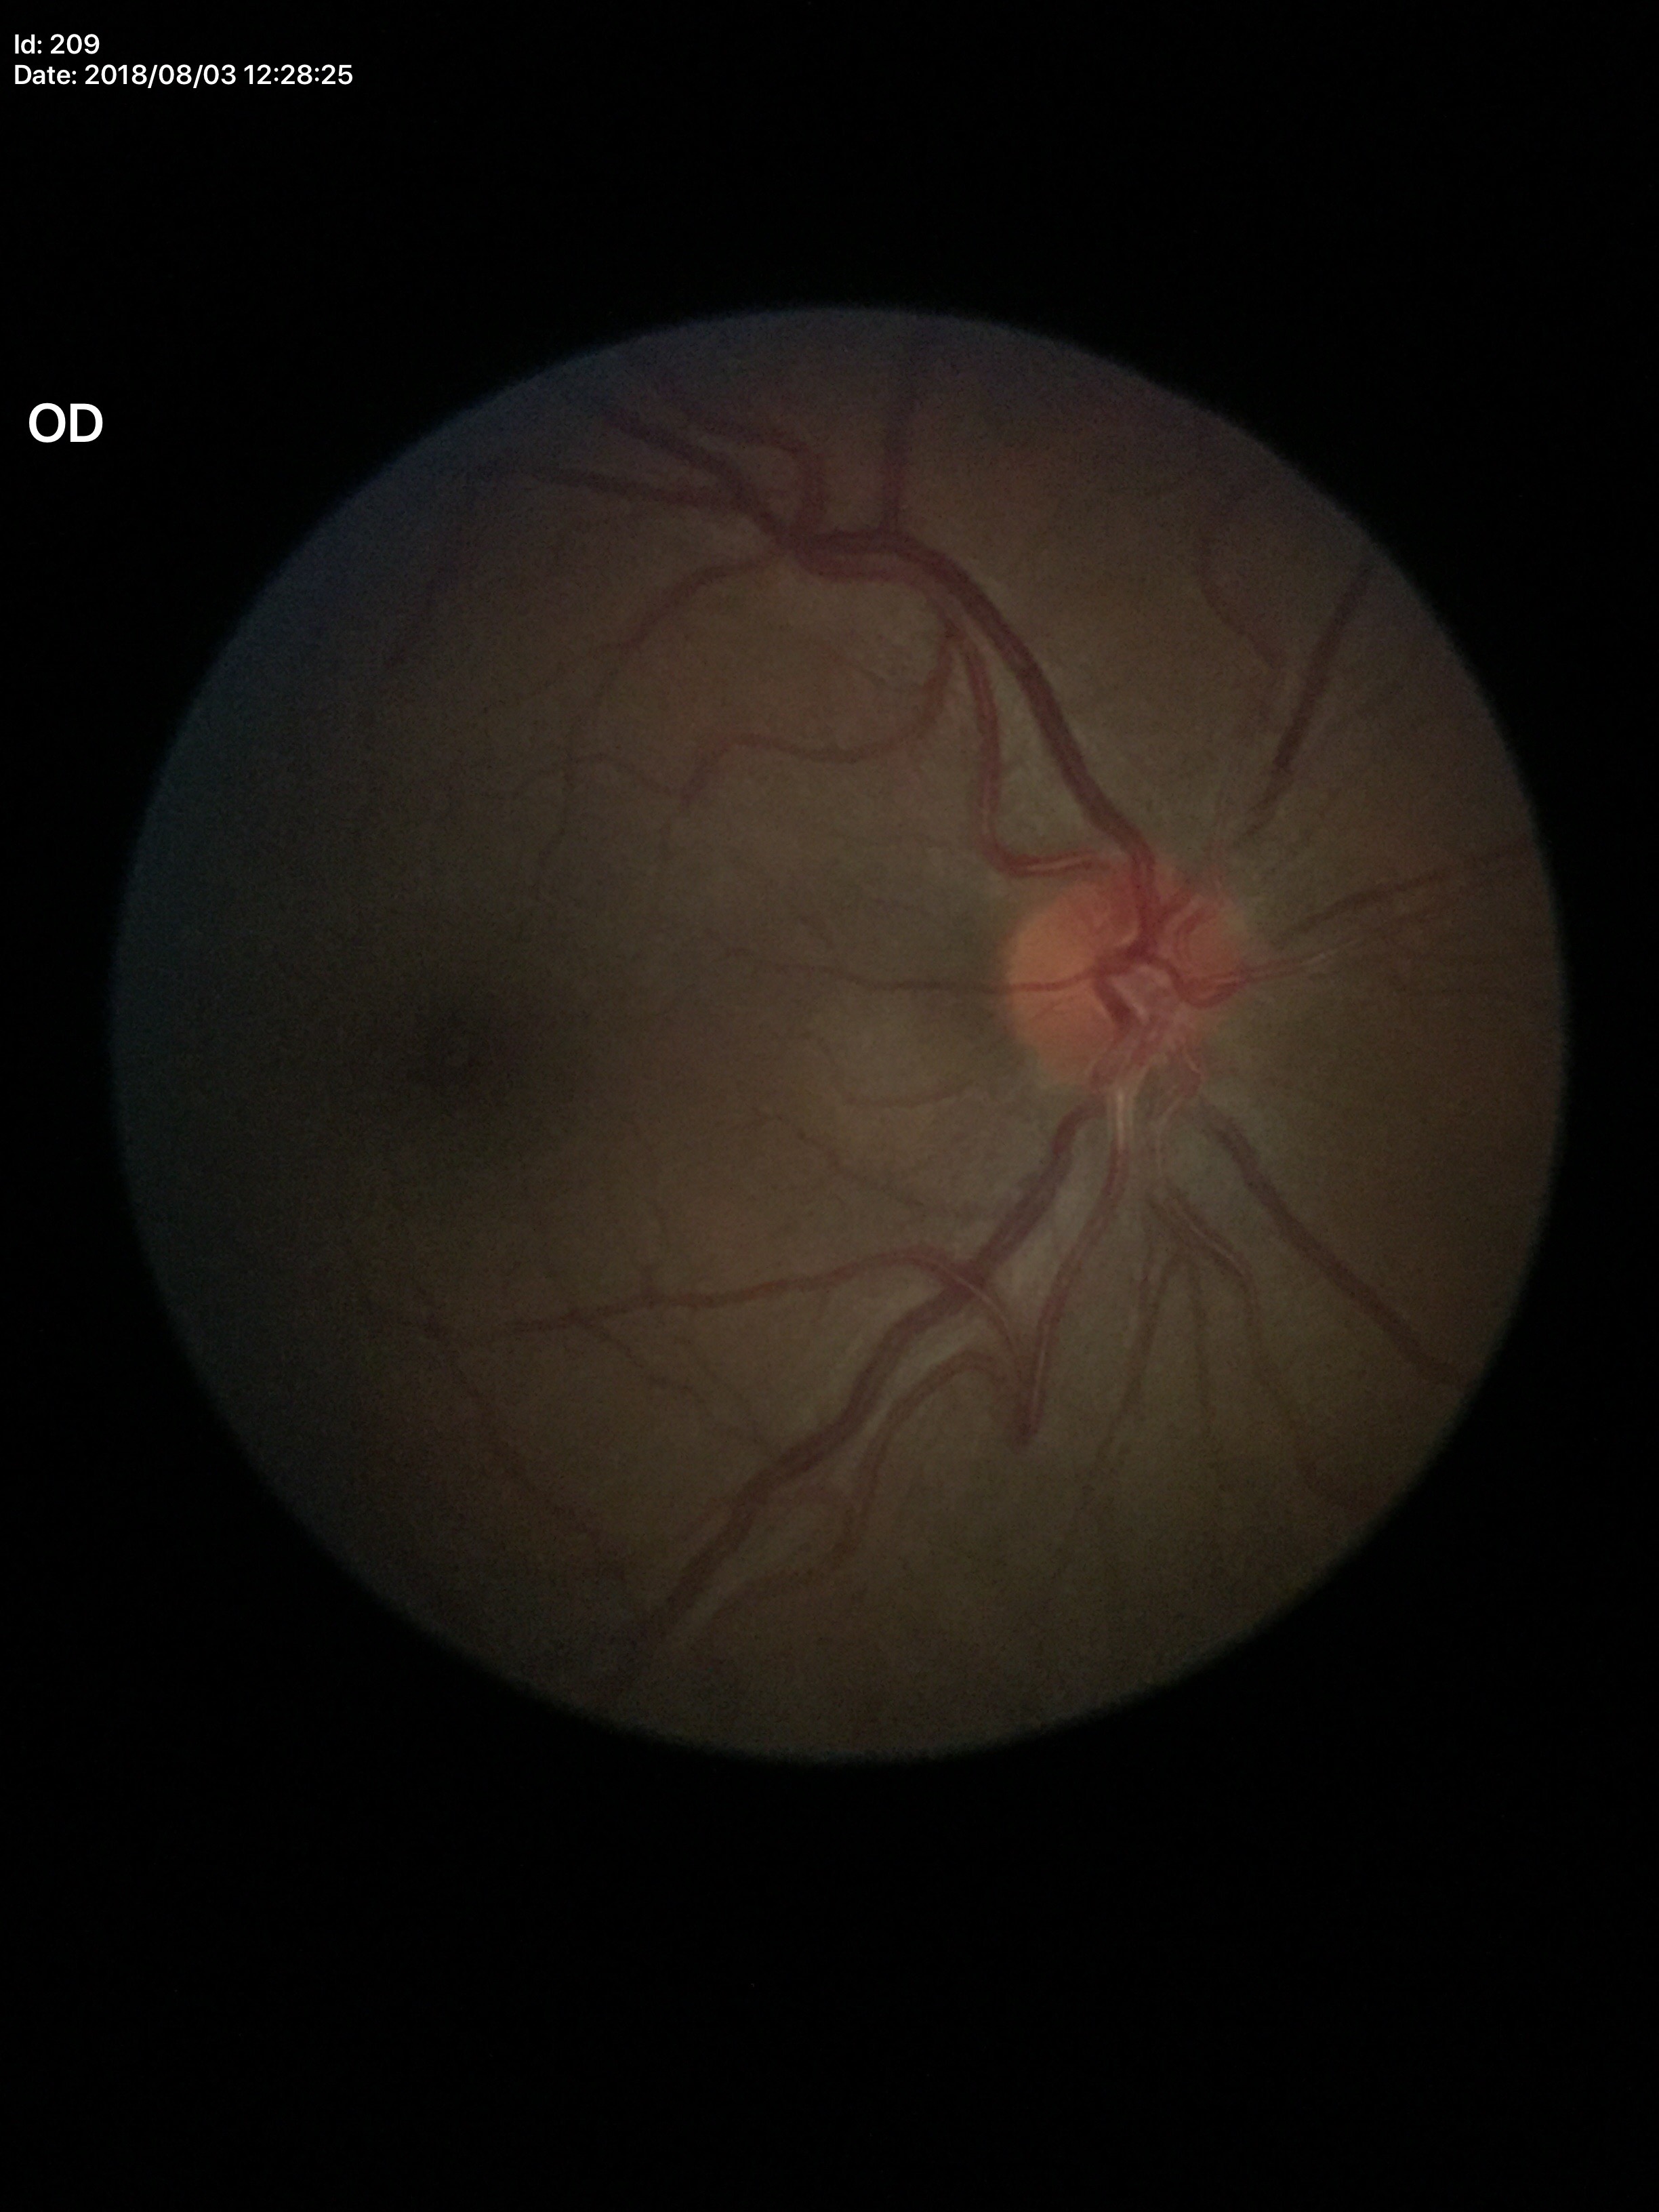
• Glaucoma impression · not suspect (unanimous normal call)
• vertical cup-disc ratio (VCDR) · 0.38